Nonmydriatic fundus photograph · modified Davis classification · posterior pole photograph — 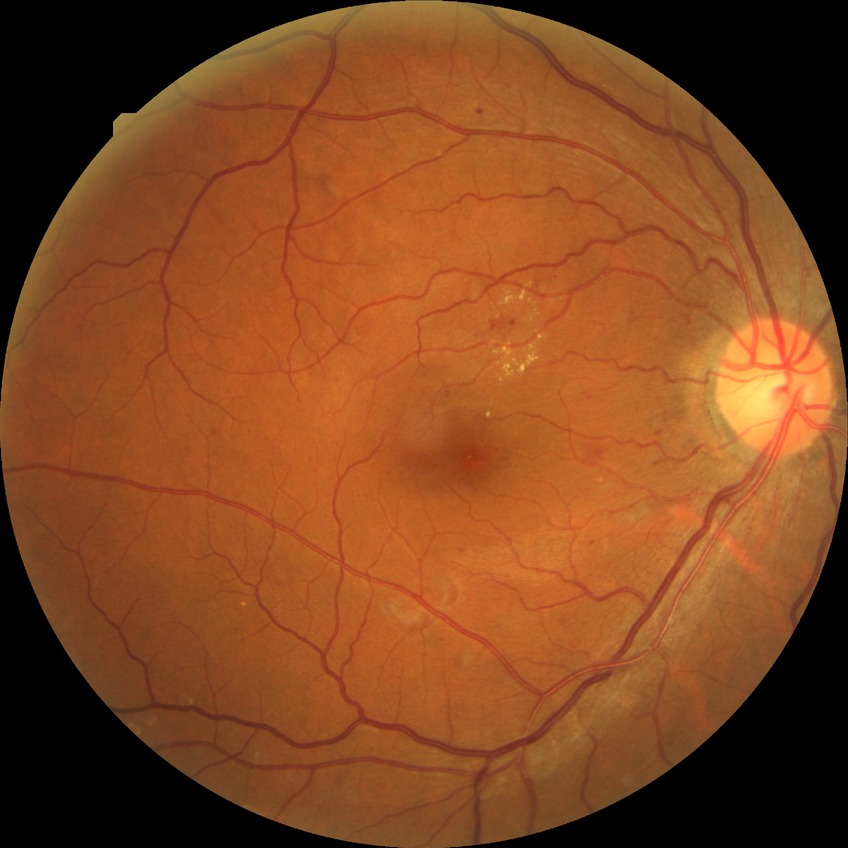

DR severity is SDR.